848 x 848 pixels · modified Davis classification: 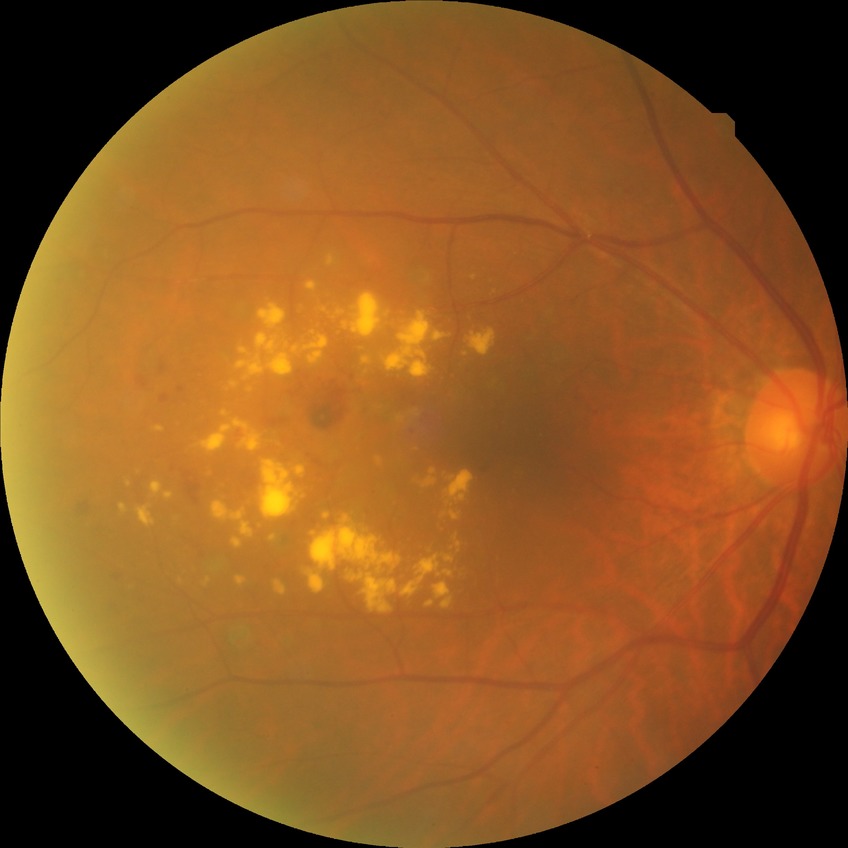

Davis grading: simple diabetic retinopathy.
DR class: non-proliferative diabetic retinopathy.